Wide-field contact fundus photograph of an infant — 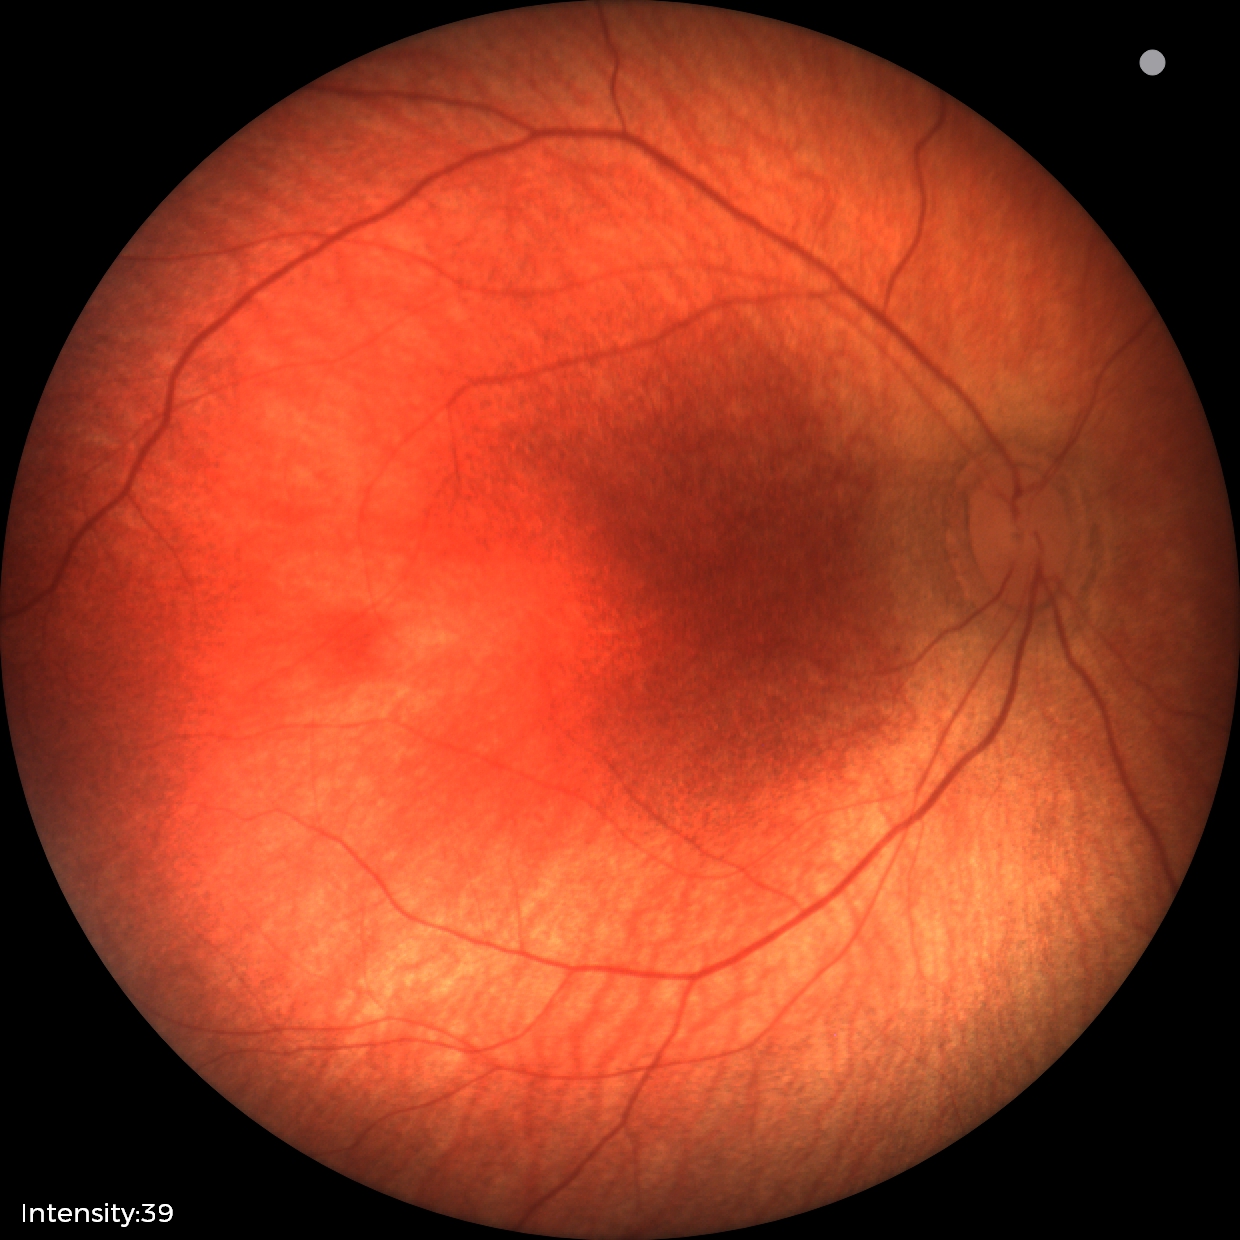

Screening examination diagnosed as physiological.